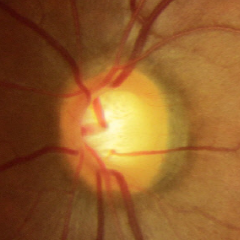 Glaucoma status: no glaucomatous changes.